2048x1536px: 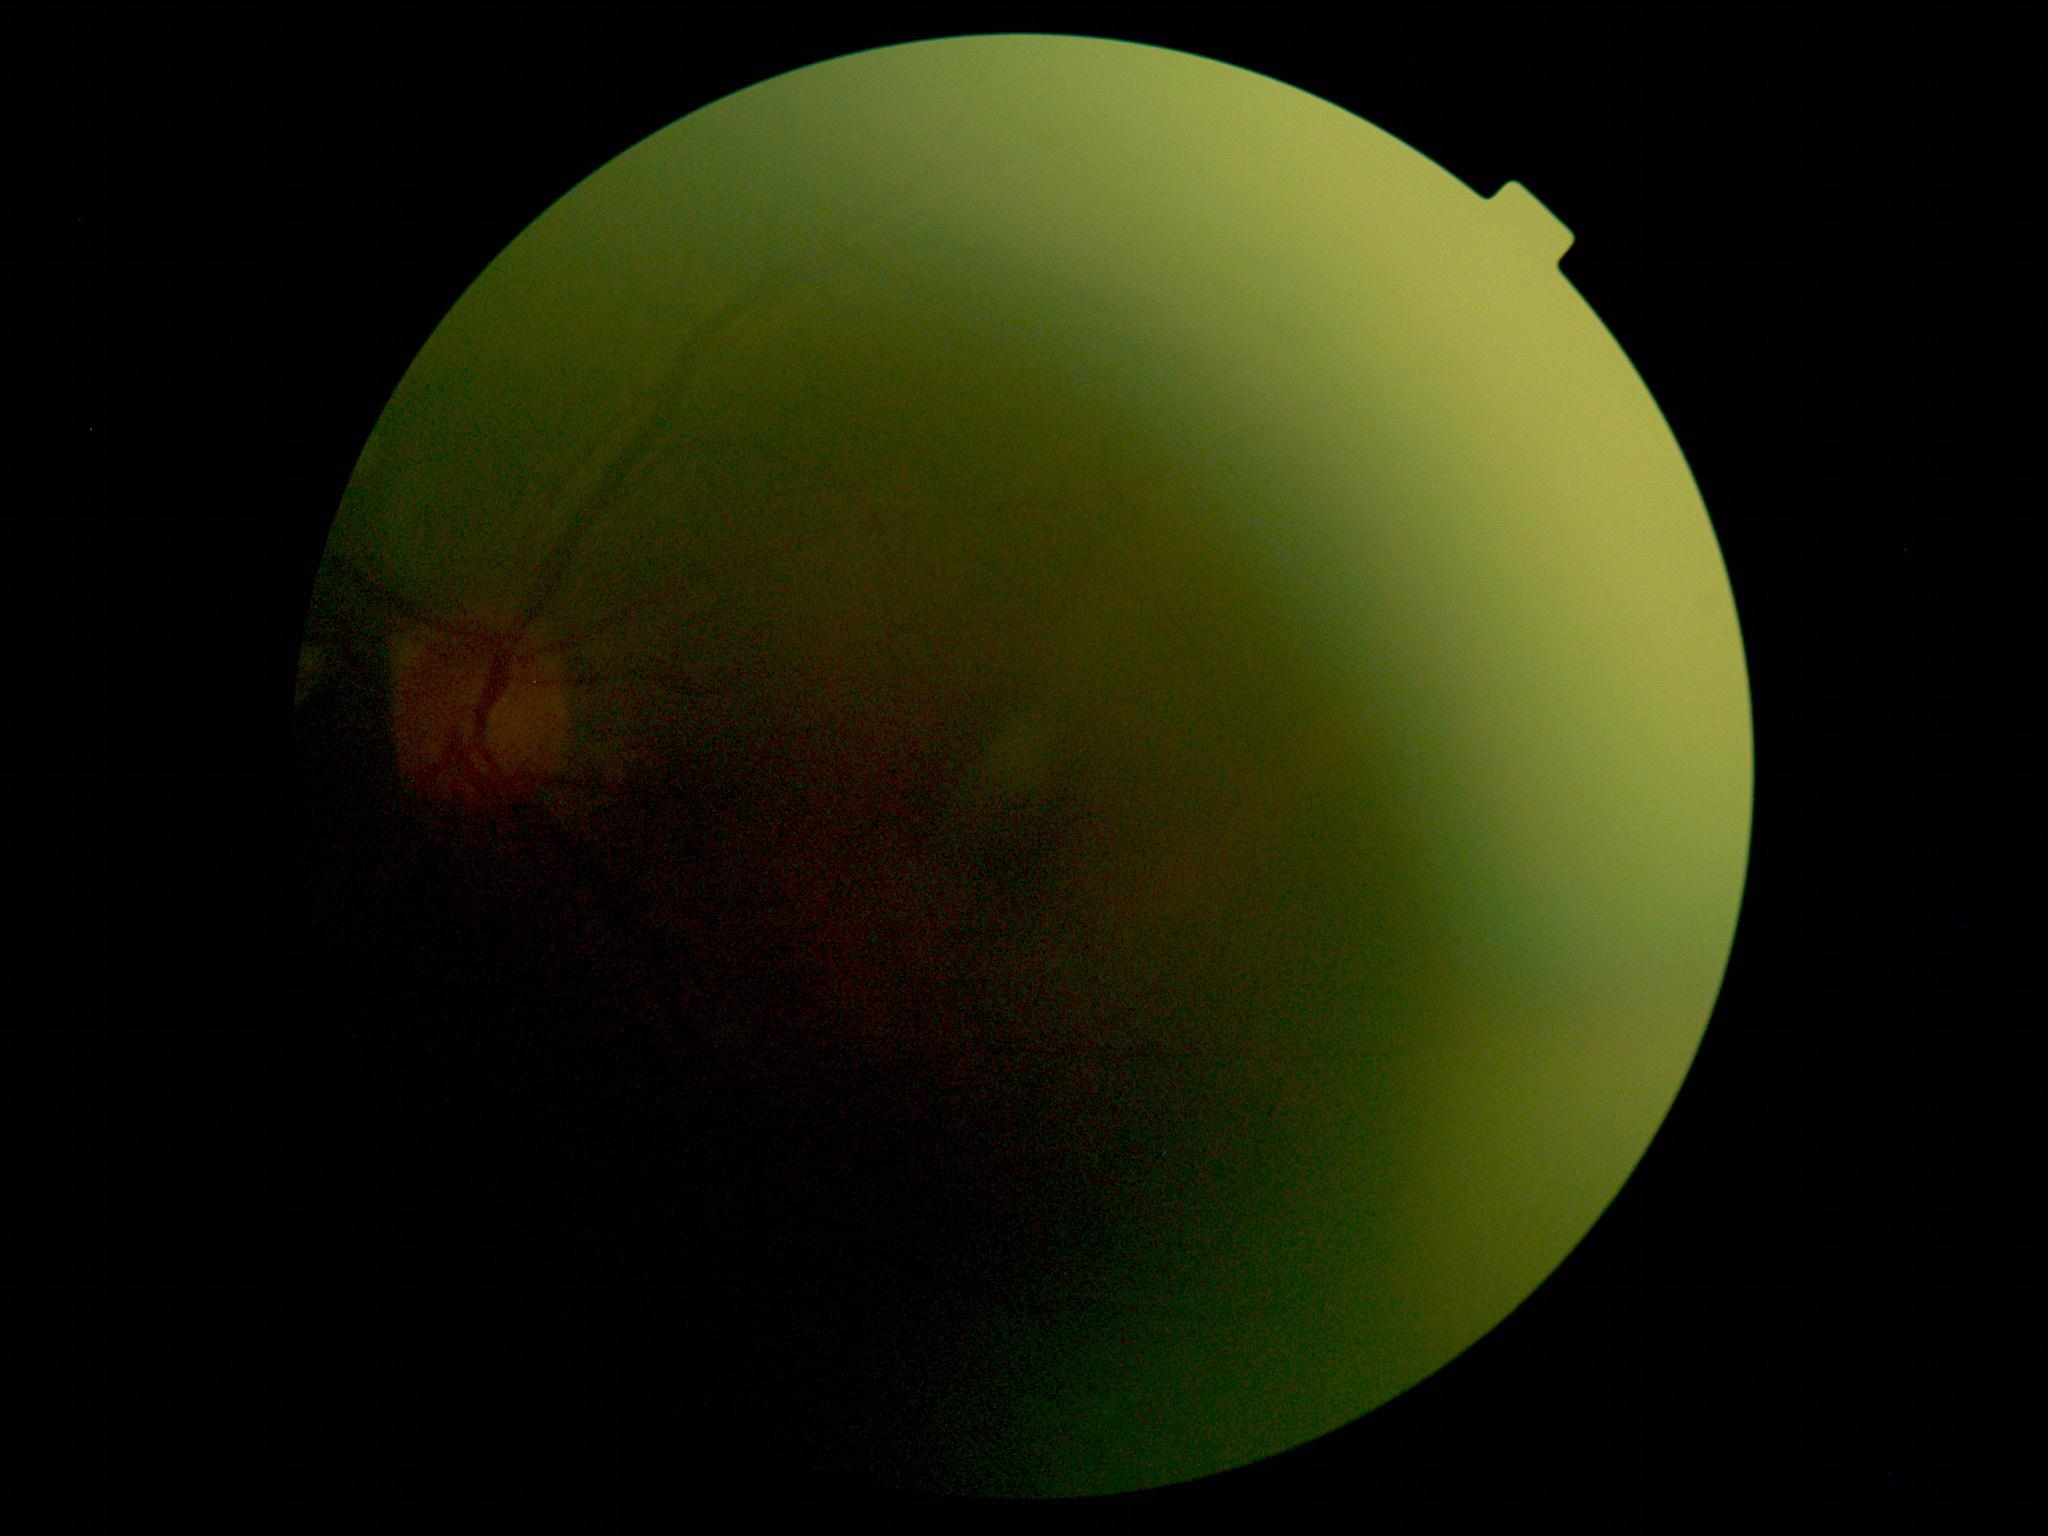

DR stage is ungradable due to poor image quality.